1440 by 1080 pixels. Wide-field contact fundus photograph of an infant
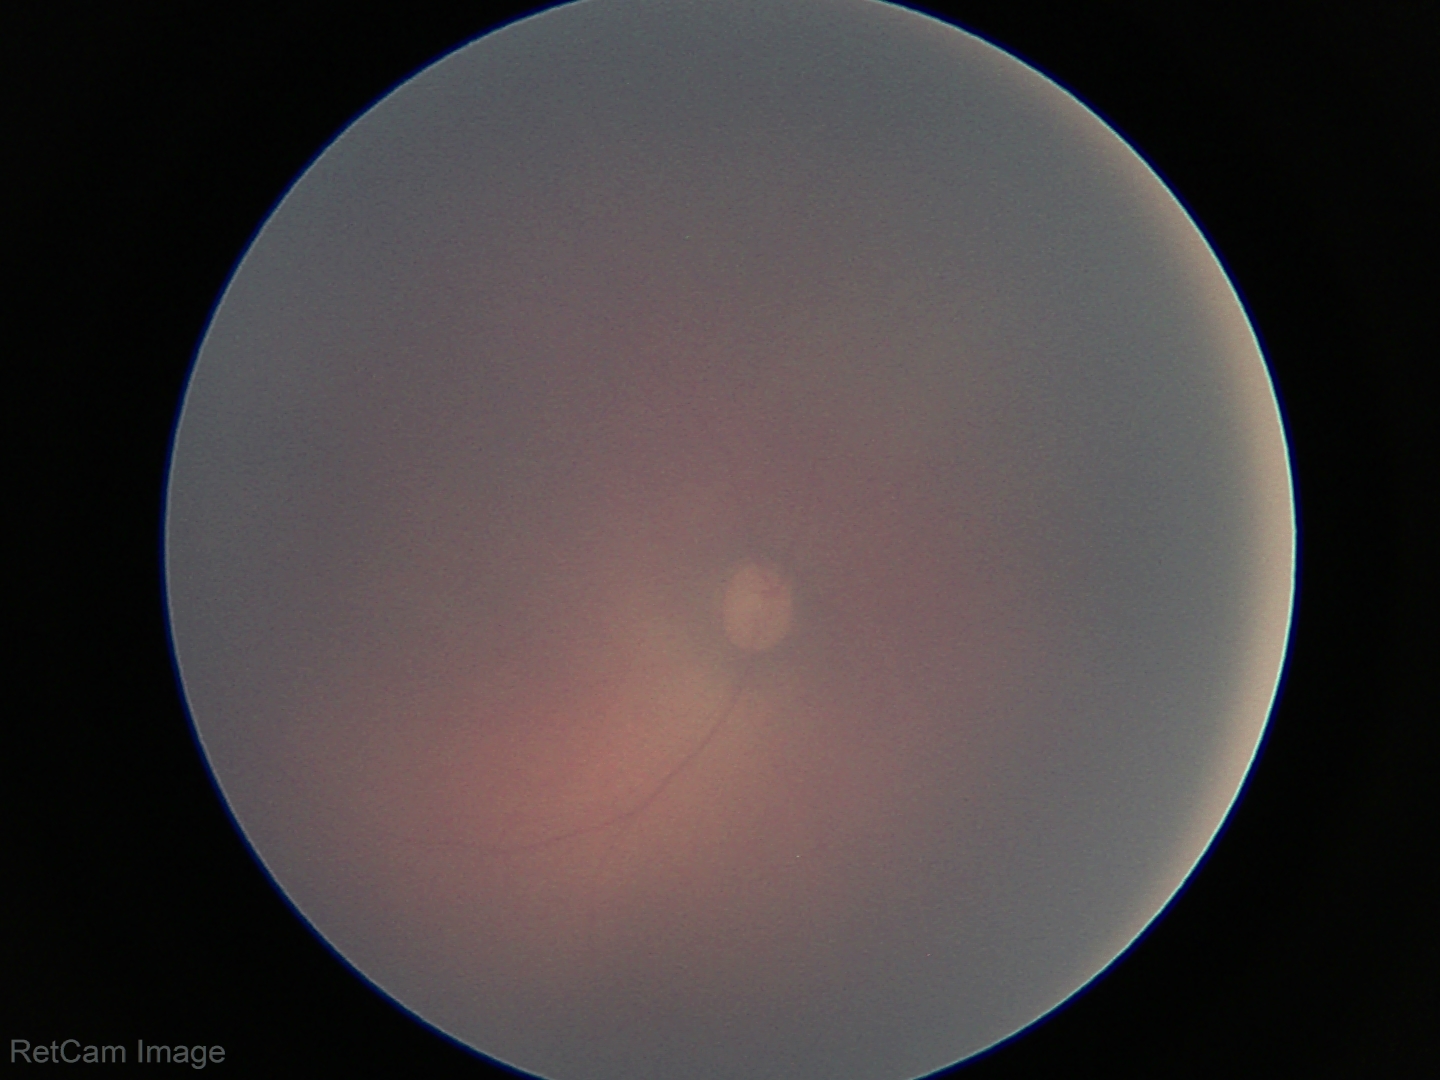
Normal screening examination.